45-degree field of view · color fundus photograph · 1515x1275
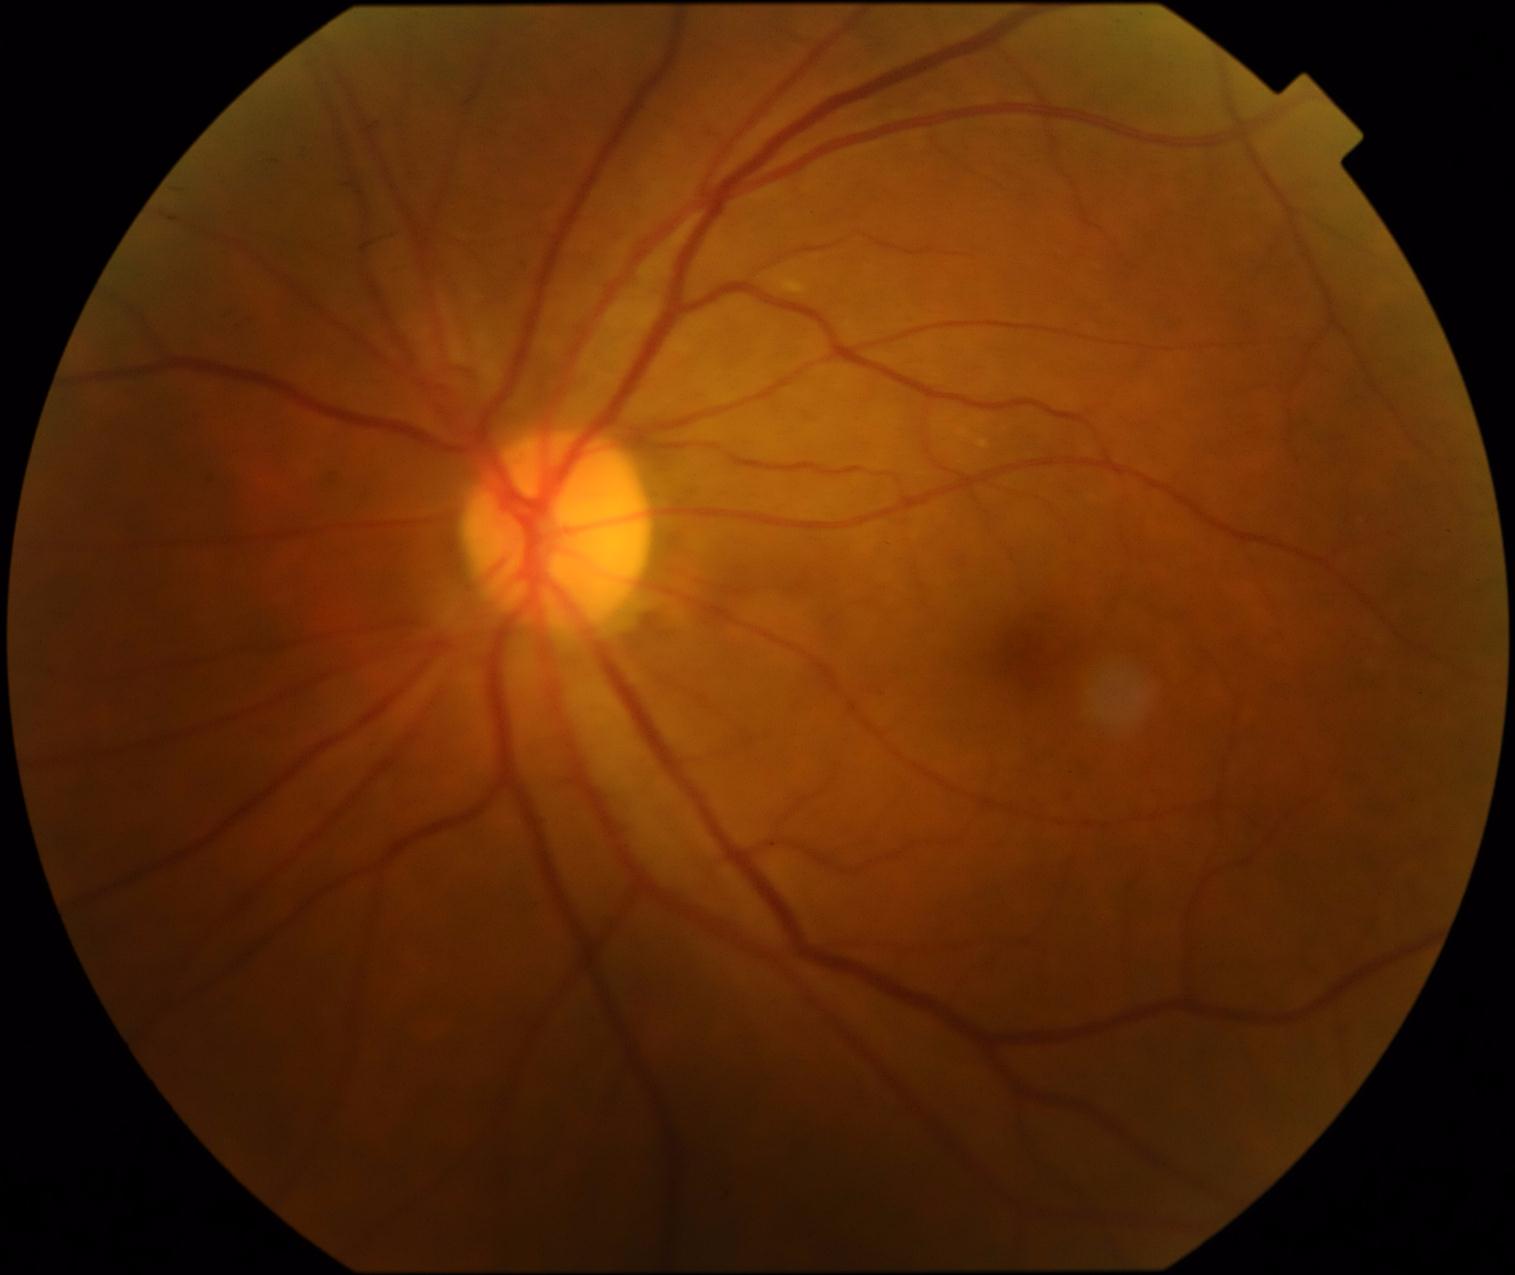

Retinopathy: no apparent diabetic retinopathy (grade 0). No signs of diabetic retinopathy.